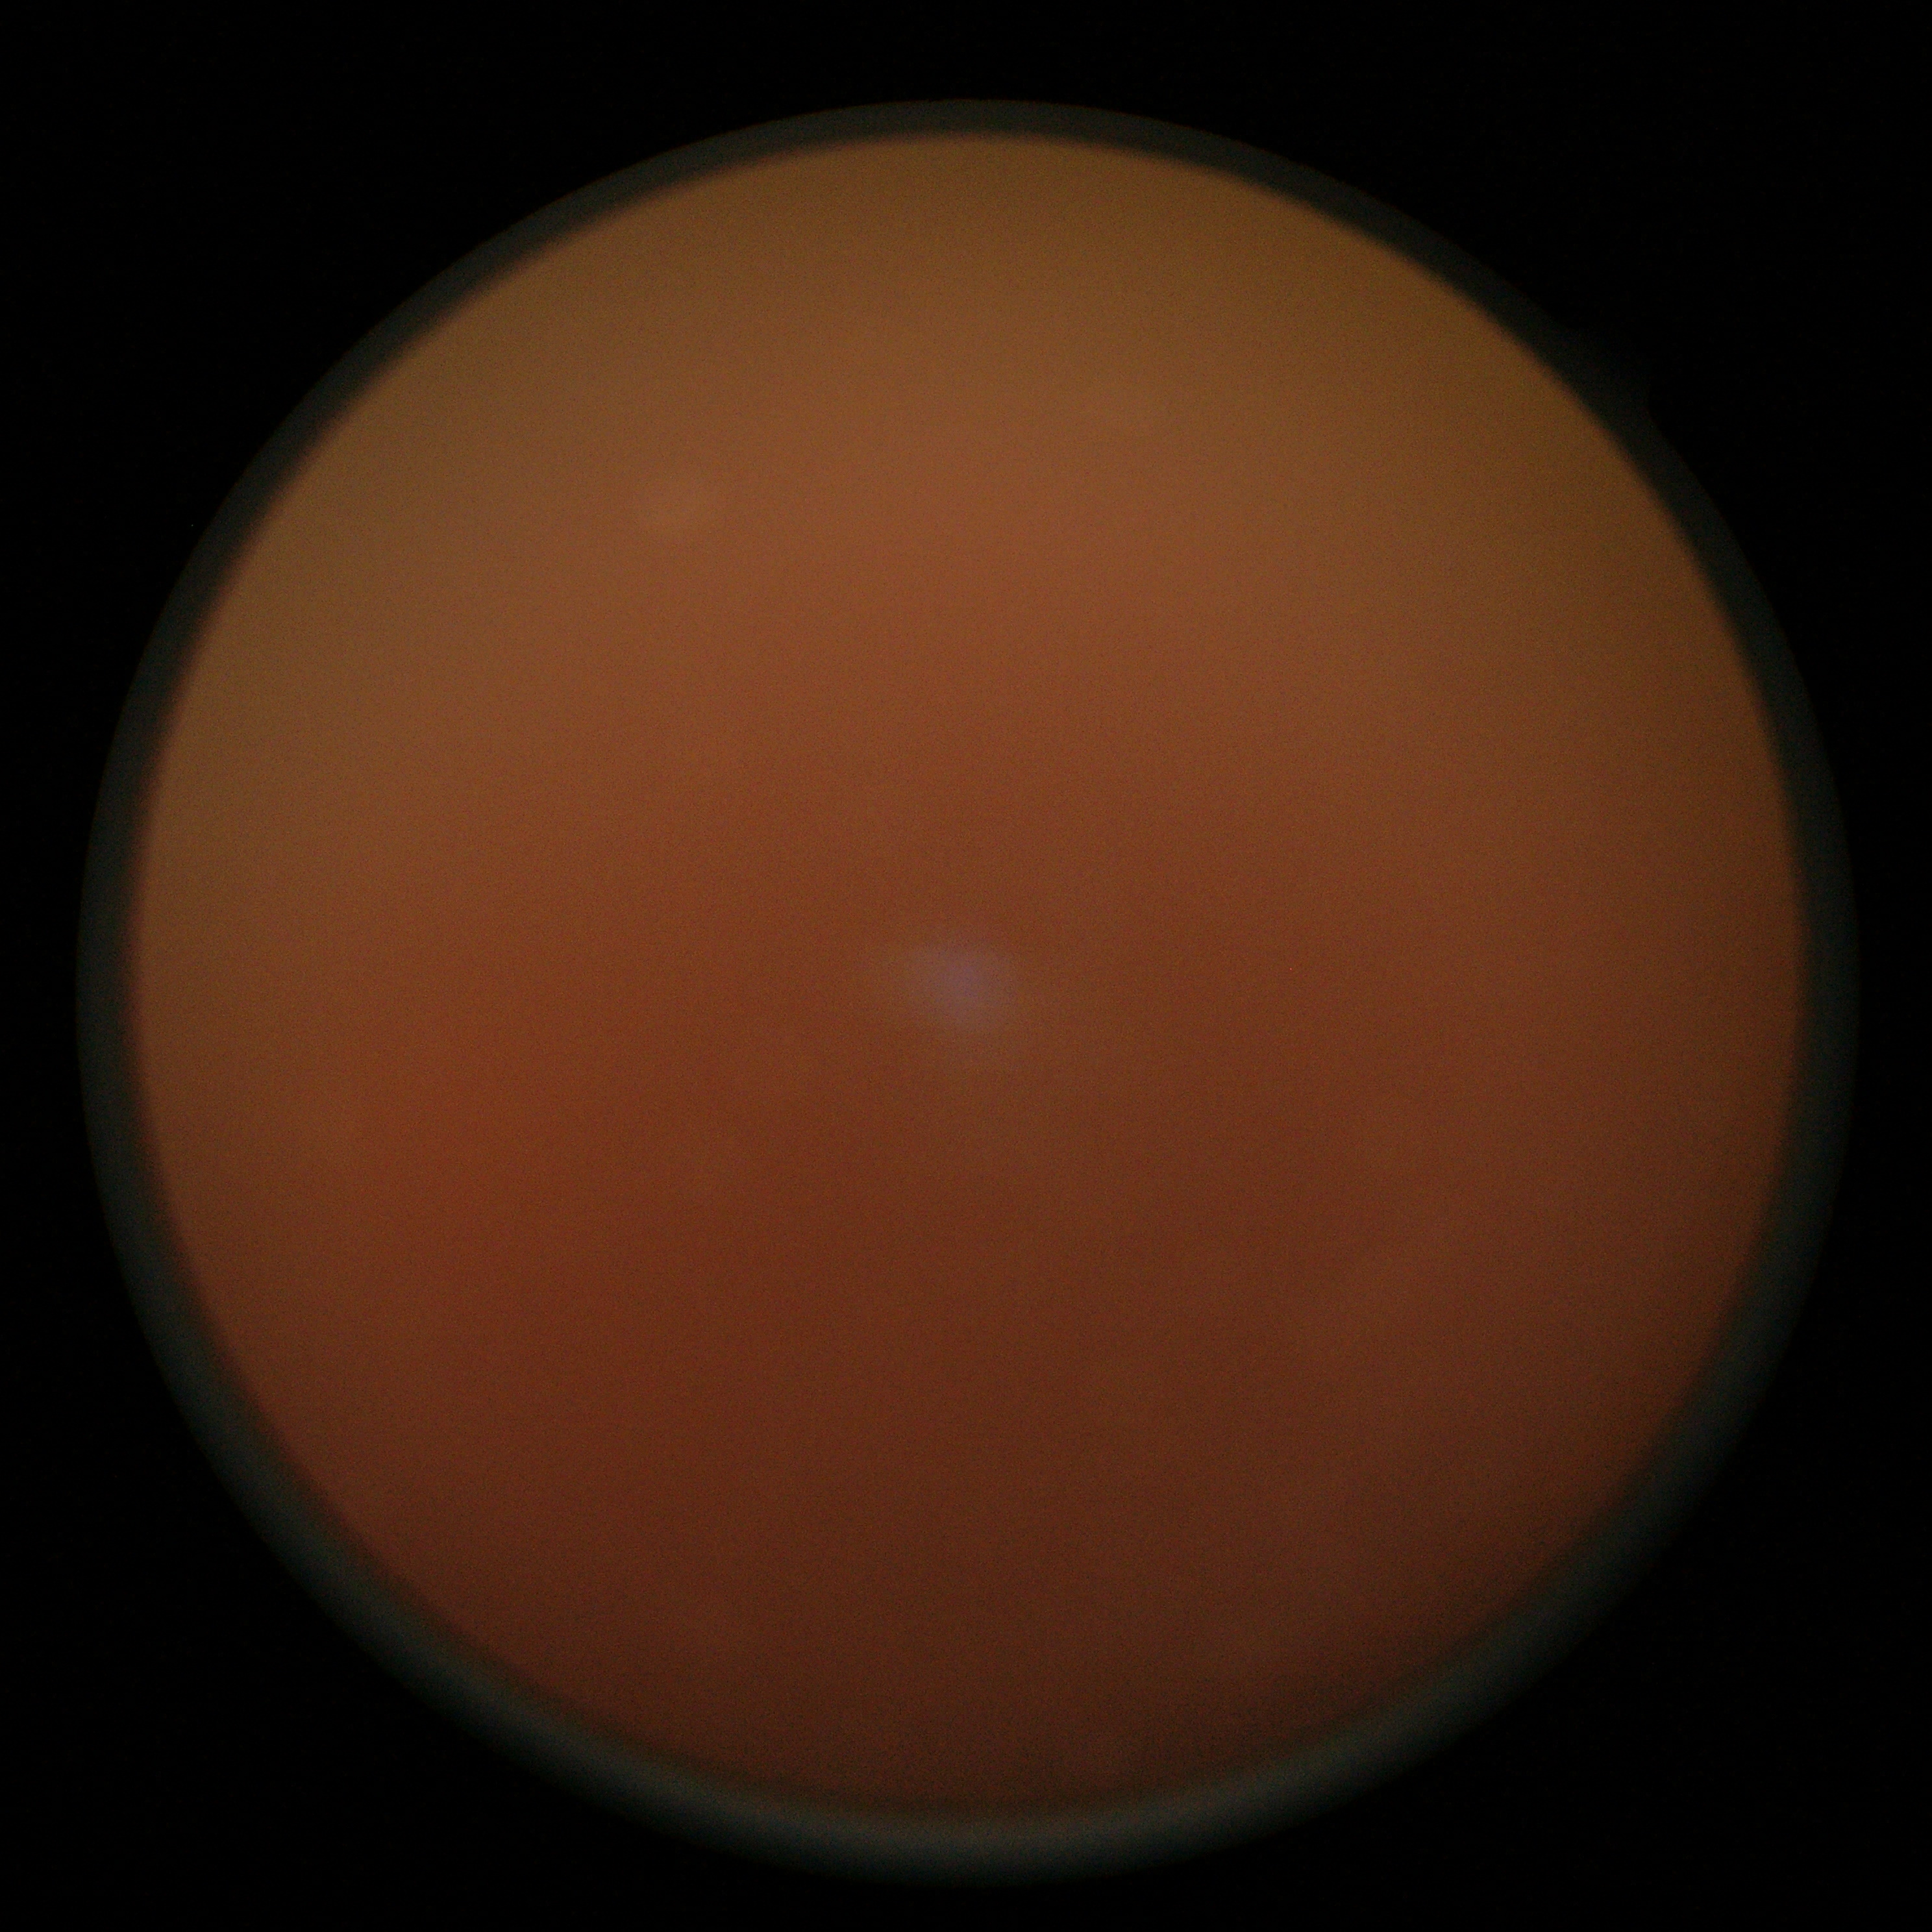

The image cannot be graded for diabetic retinopathy. DR is ungradable due to poor image quality.